Wide-field fundus photograph of an infant.
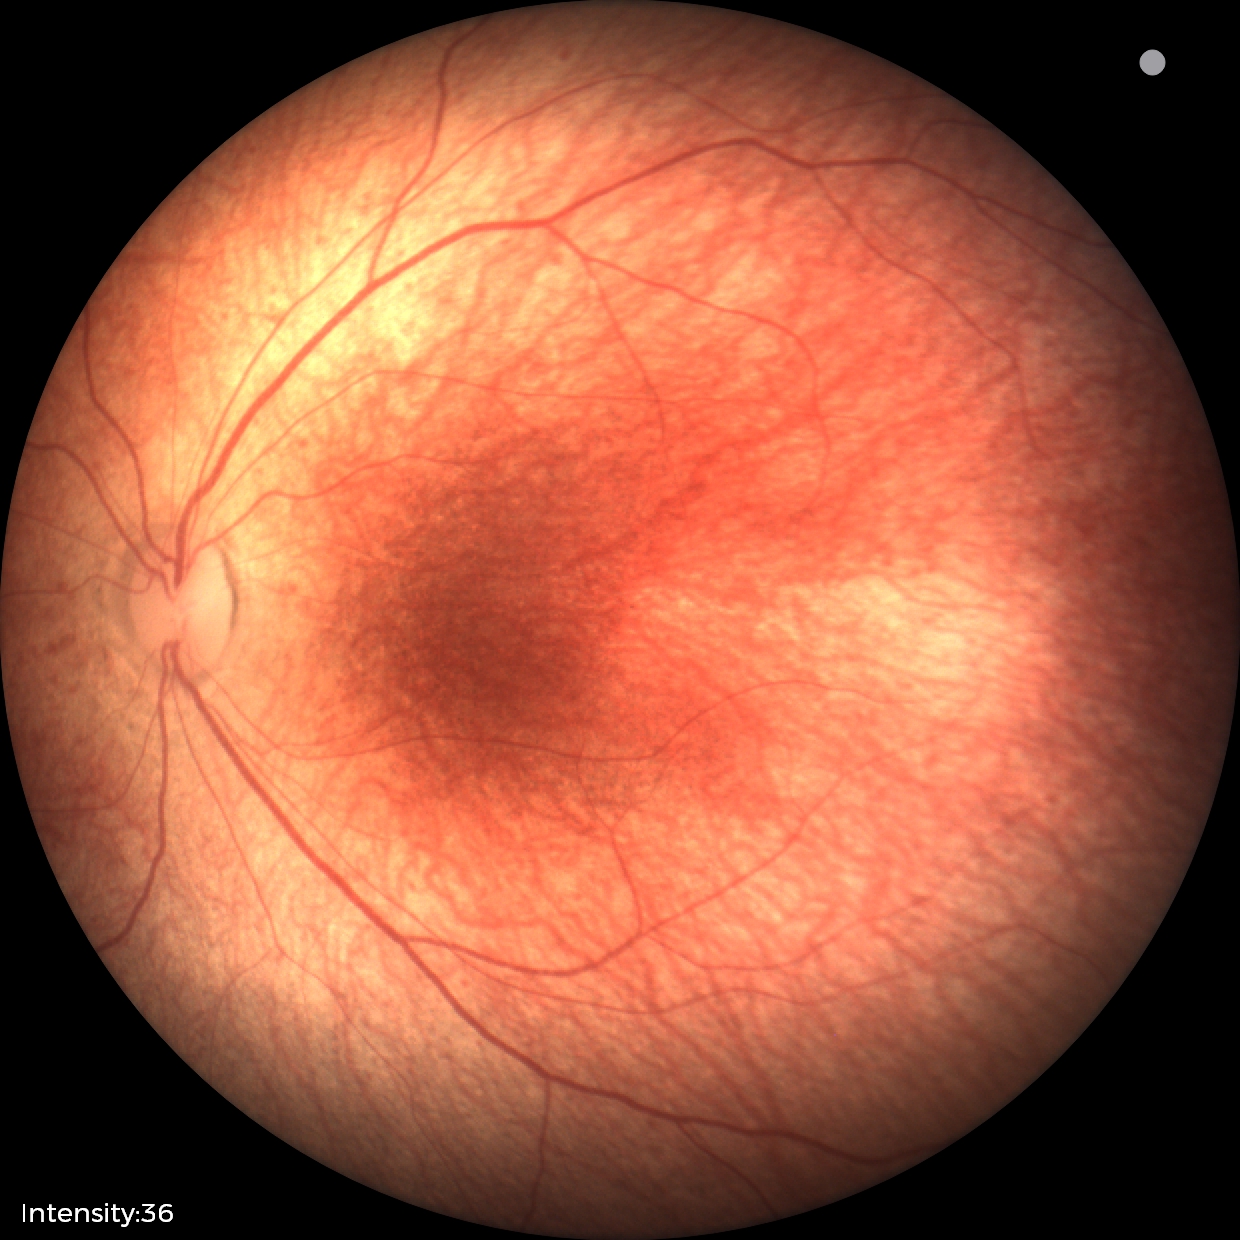

Screening examination diagnosed as physiological.